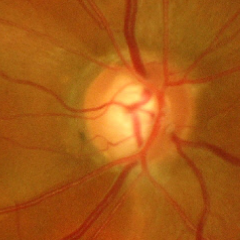 Glaucomatous changes are present.
Advanced glaucomatous optic neuropathy.